Captured with the Clarity RetCam 3 (130° field of view); 640x480px; infant wide-field retinal image — 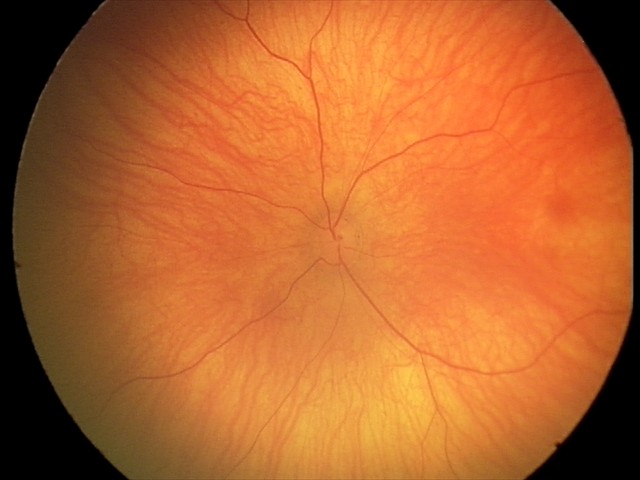
Examination with physiological retinal findings.